Wide-field fundus photograph of an infant
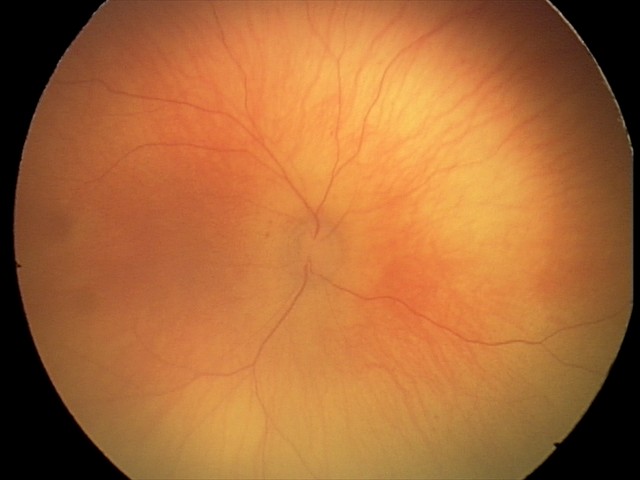

Screening: physiological finding.